45-degree field of view:
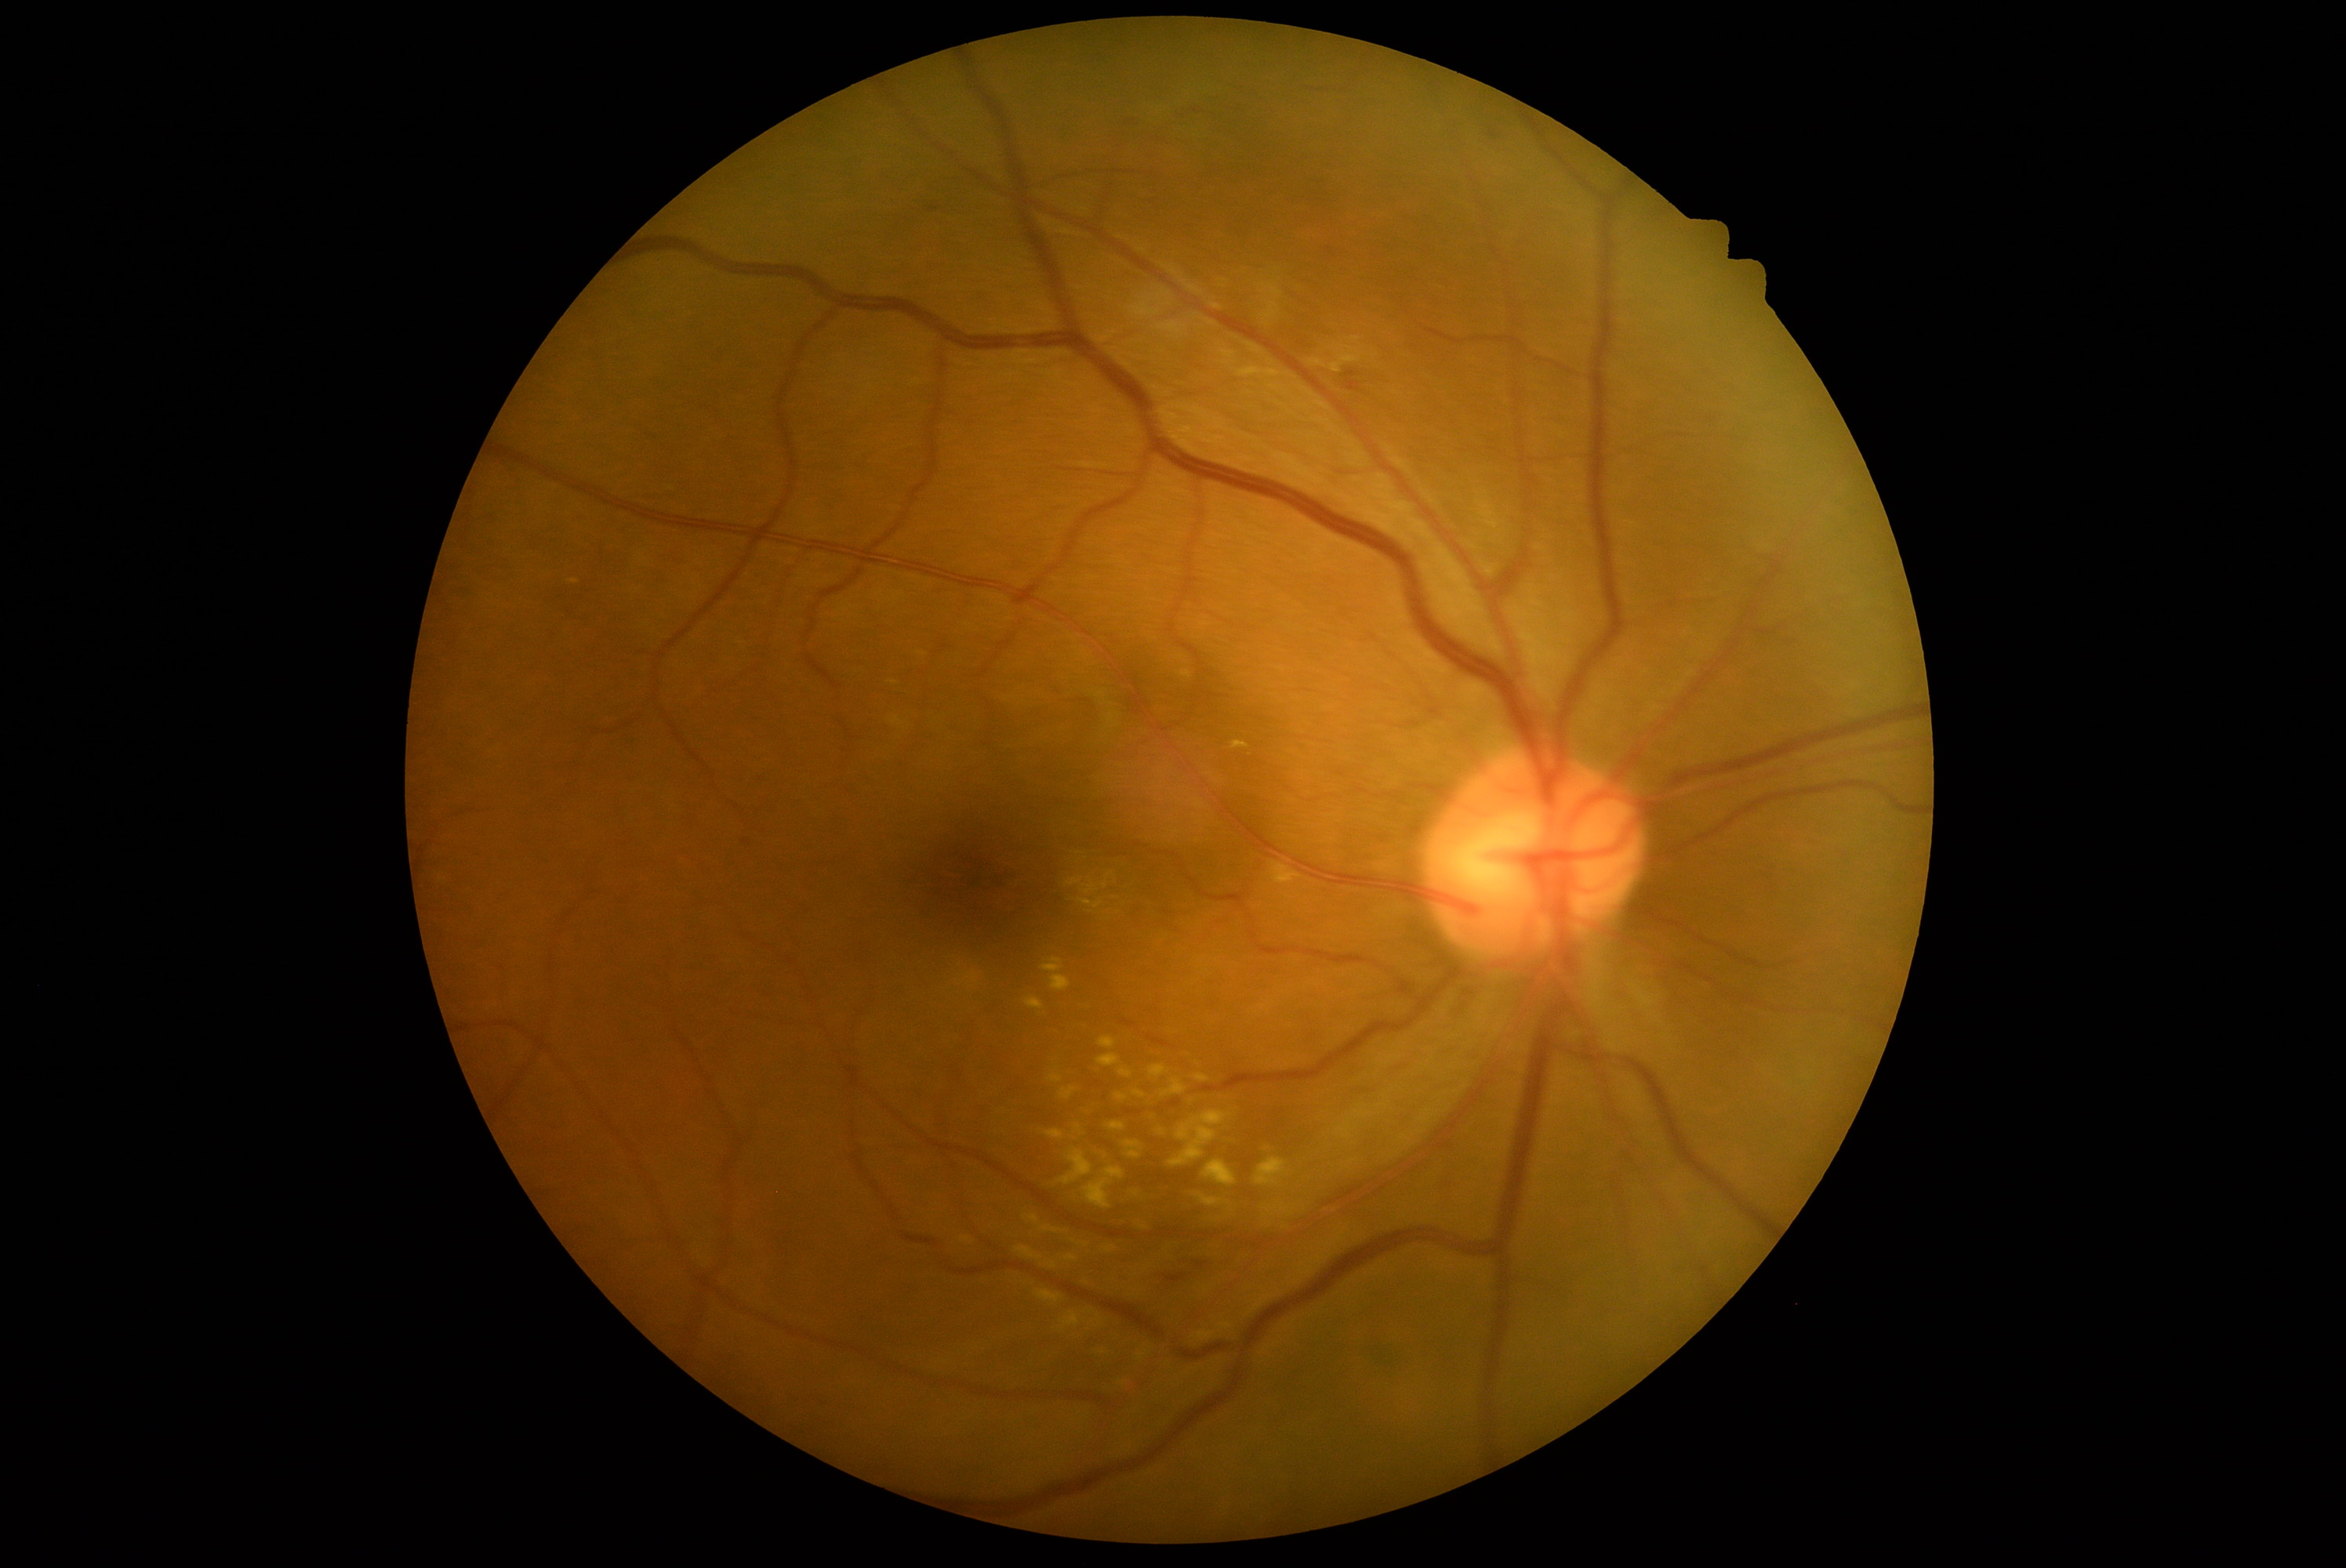

Diabetic retinopathy (DR): grade 2 (moderate NPDR).